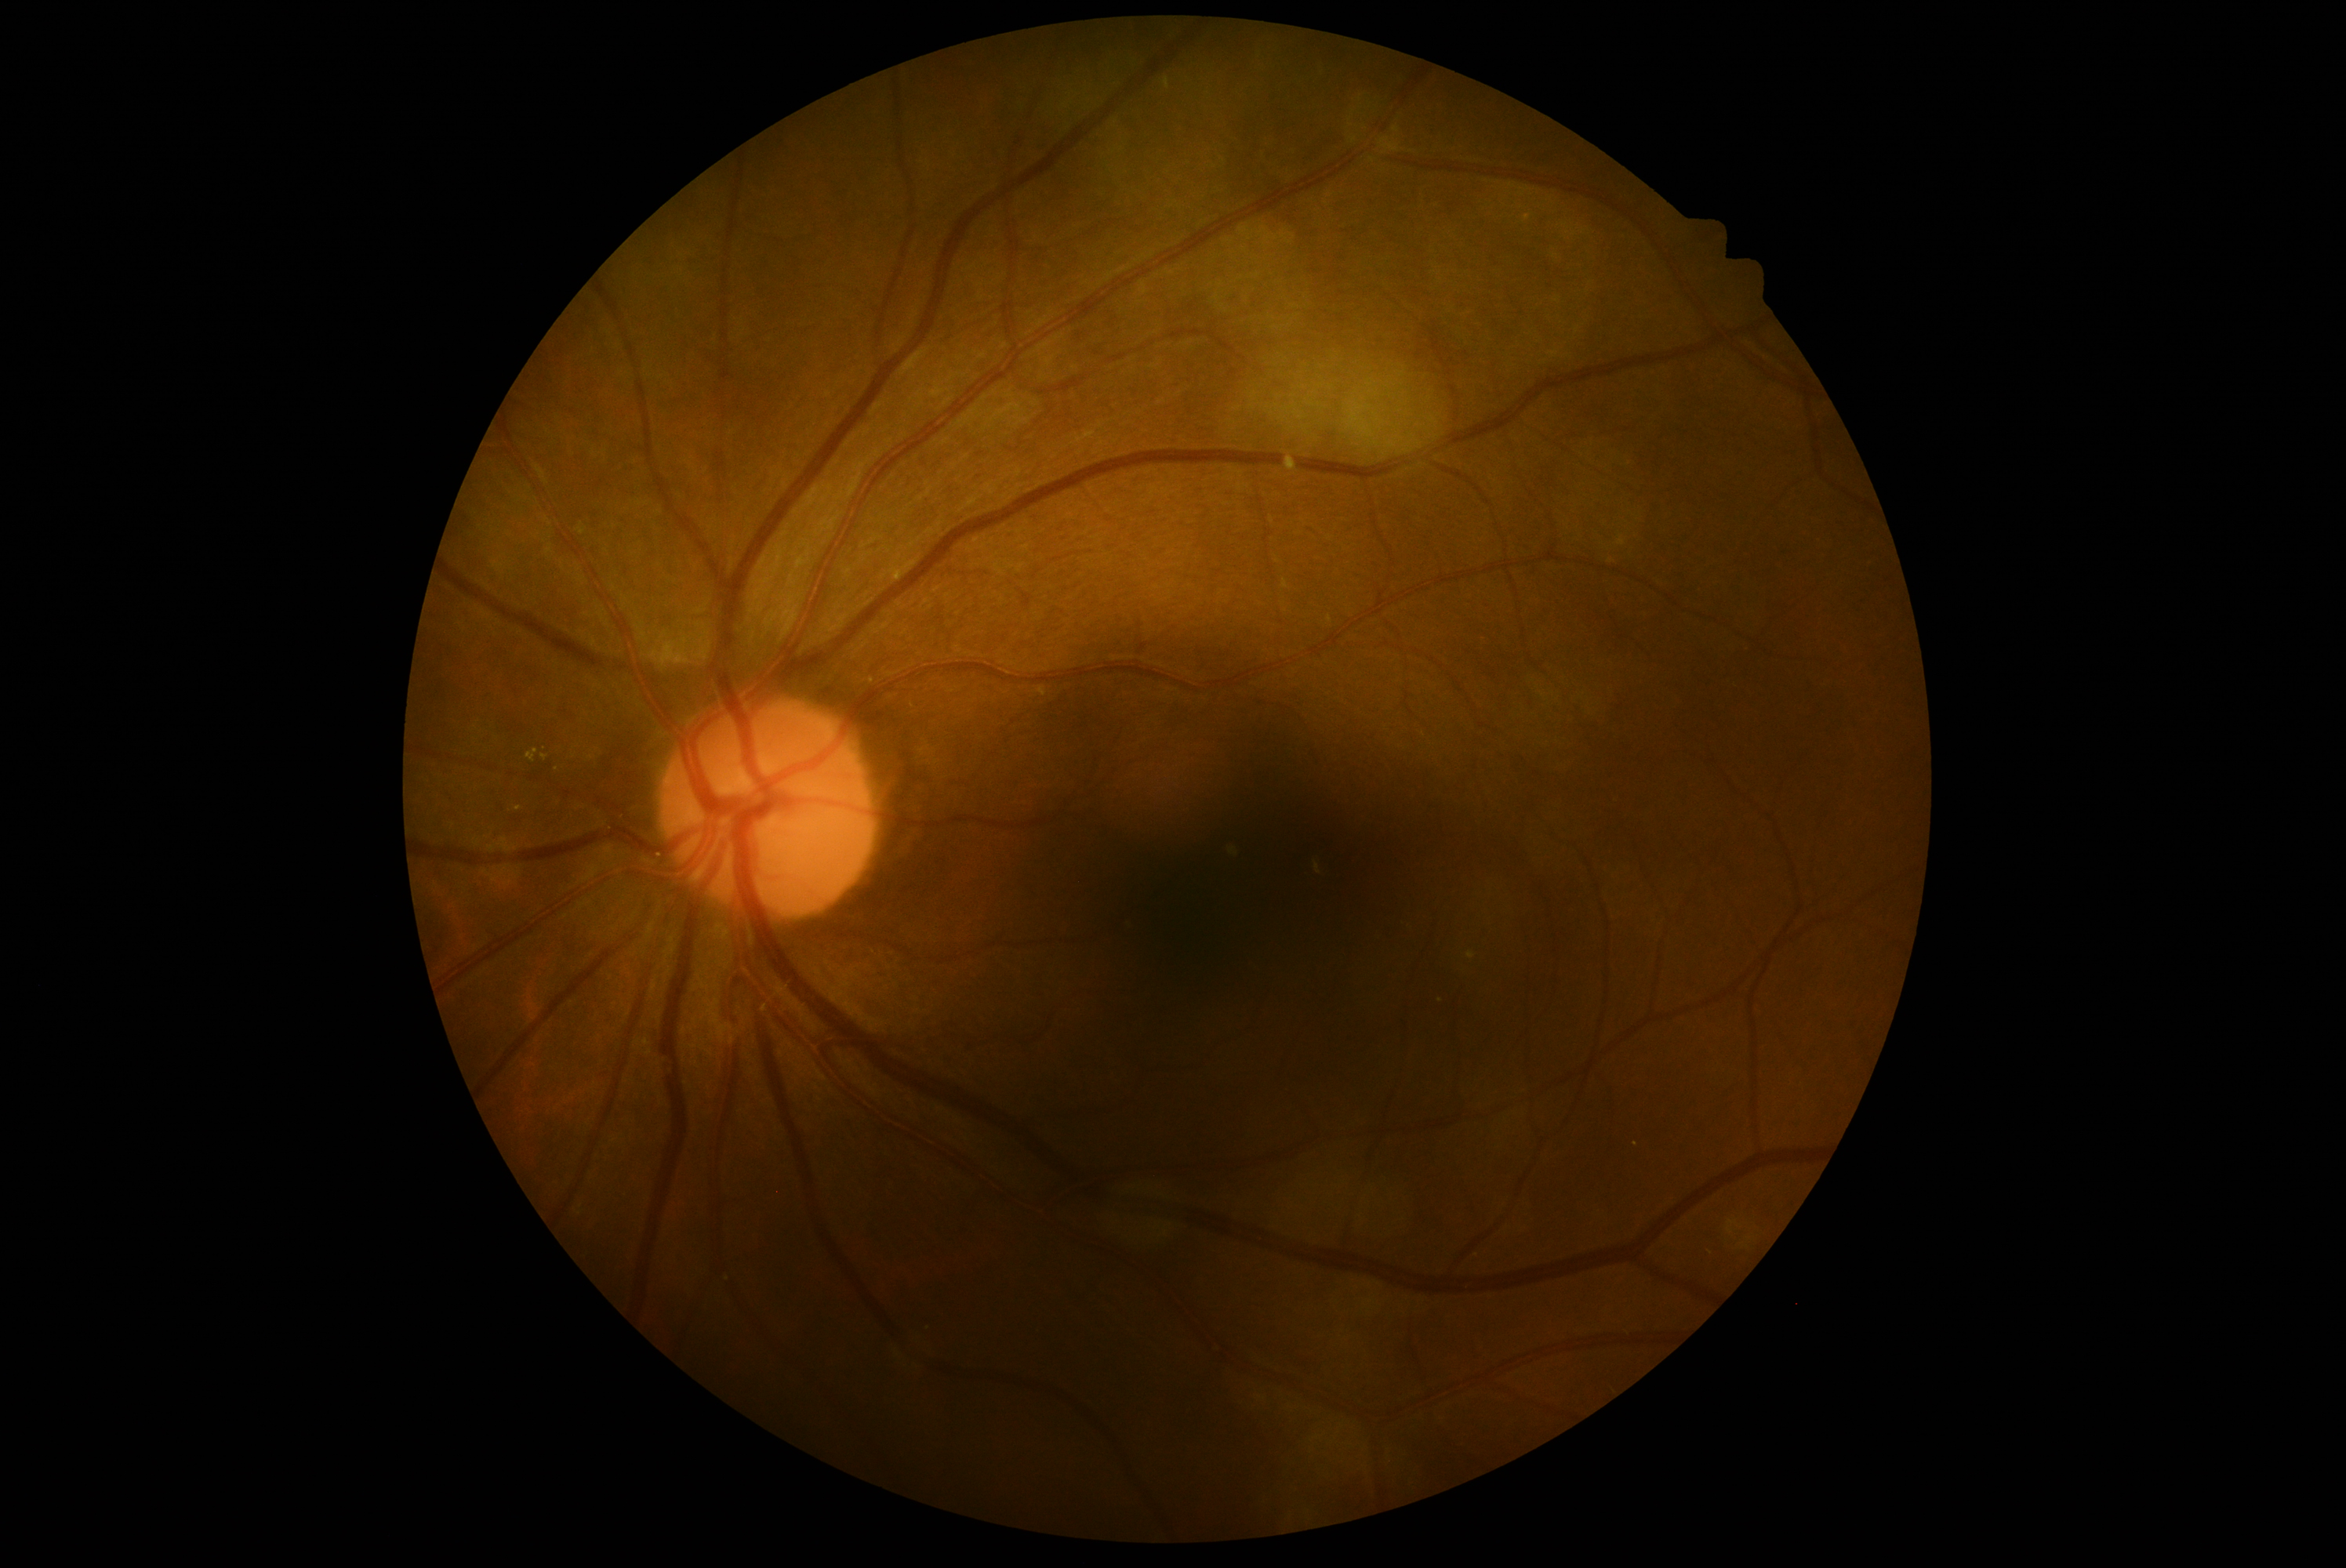
Disease class: non-proliferative diabetic retinopathy.
DR stage: moderate non-proliferative diabetic retinopathy (grade 2).